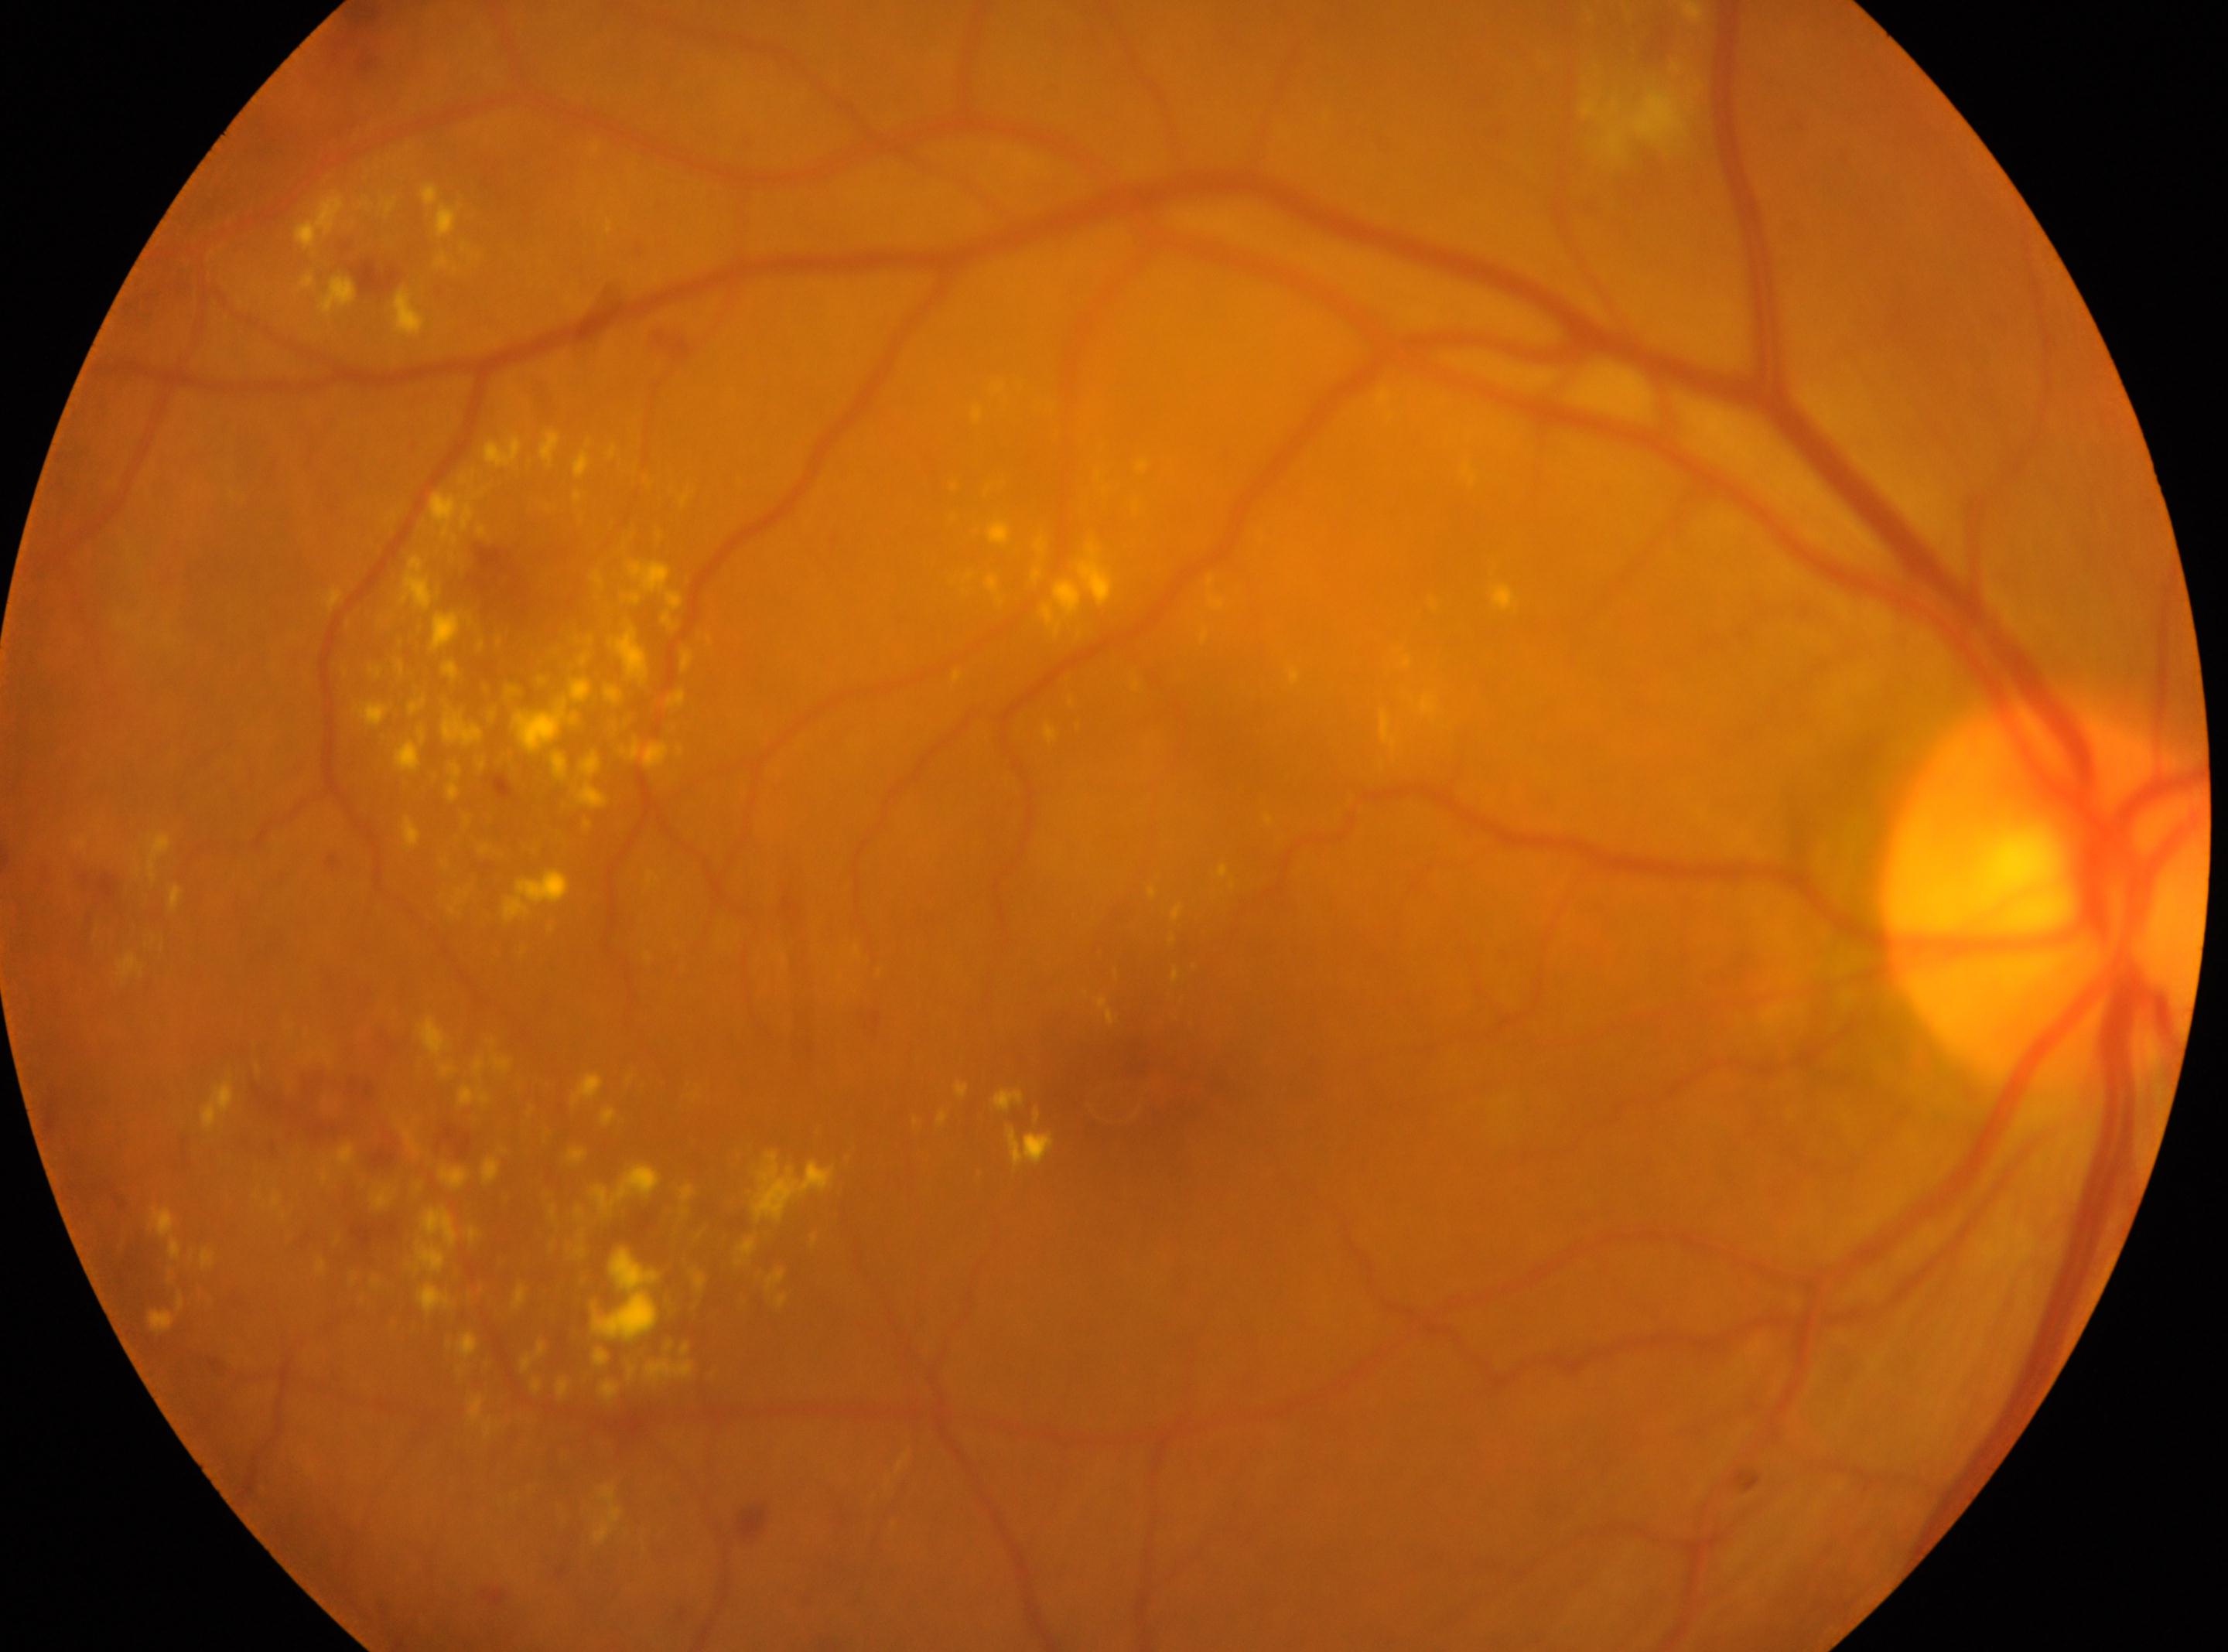

Imaged eye: OD. The optic nerve head is at (2044, 886). Macula center: (1120, 1104). Diabetic retinopathy grade: 2 (moderate NPDR).